Acquired with a NIDEK AFC-230. Posterior pole photograph. 848 by 848 pixels — 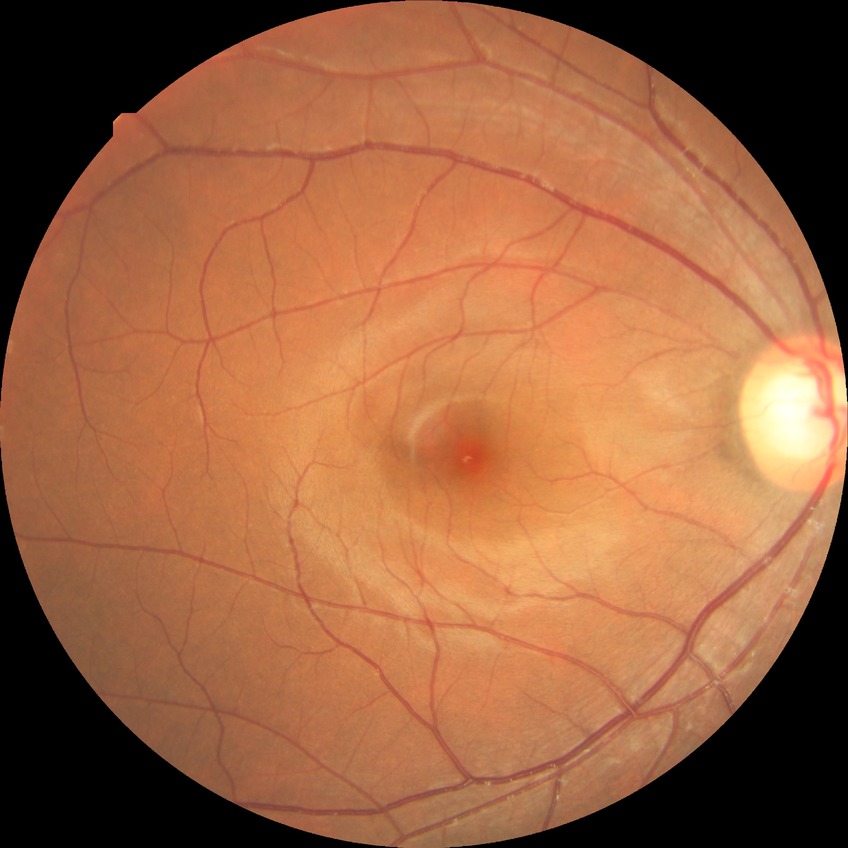

diabetic retinopathy (DR): no diabetic retinopathy (NDR).